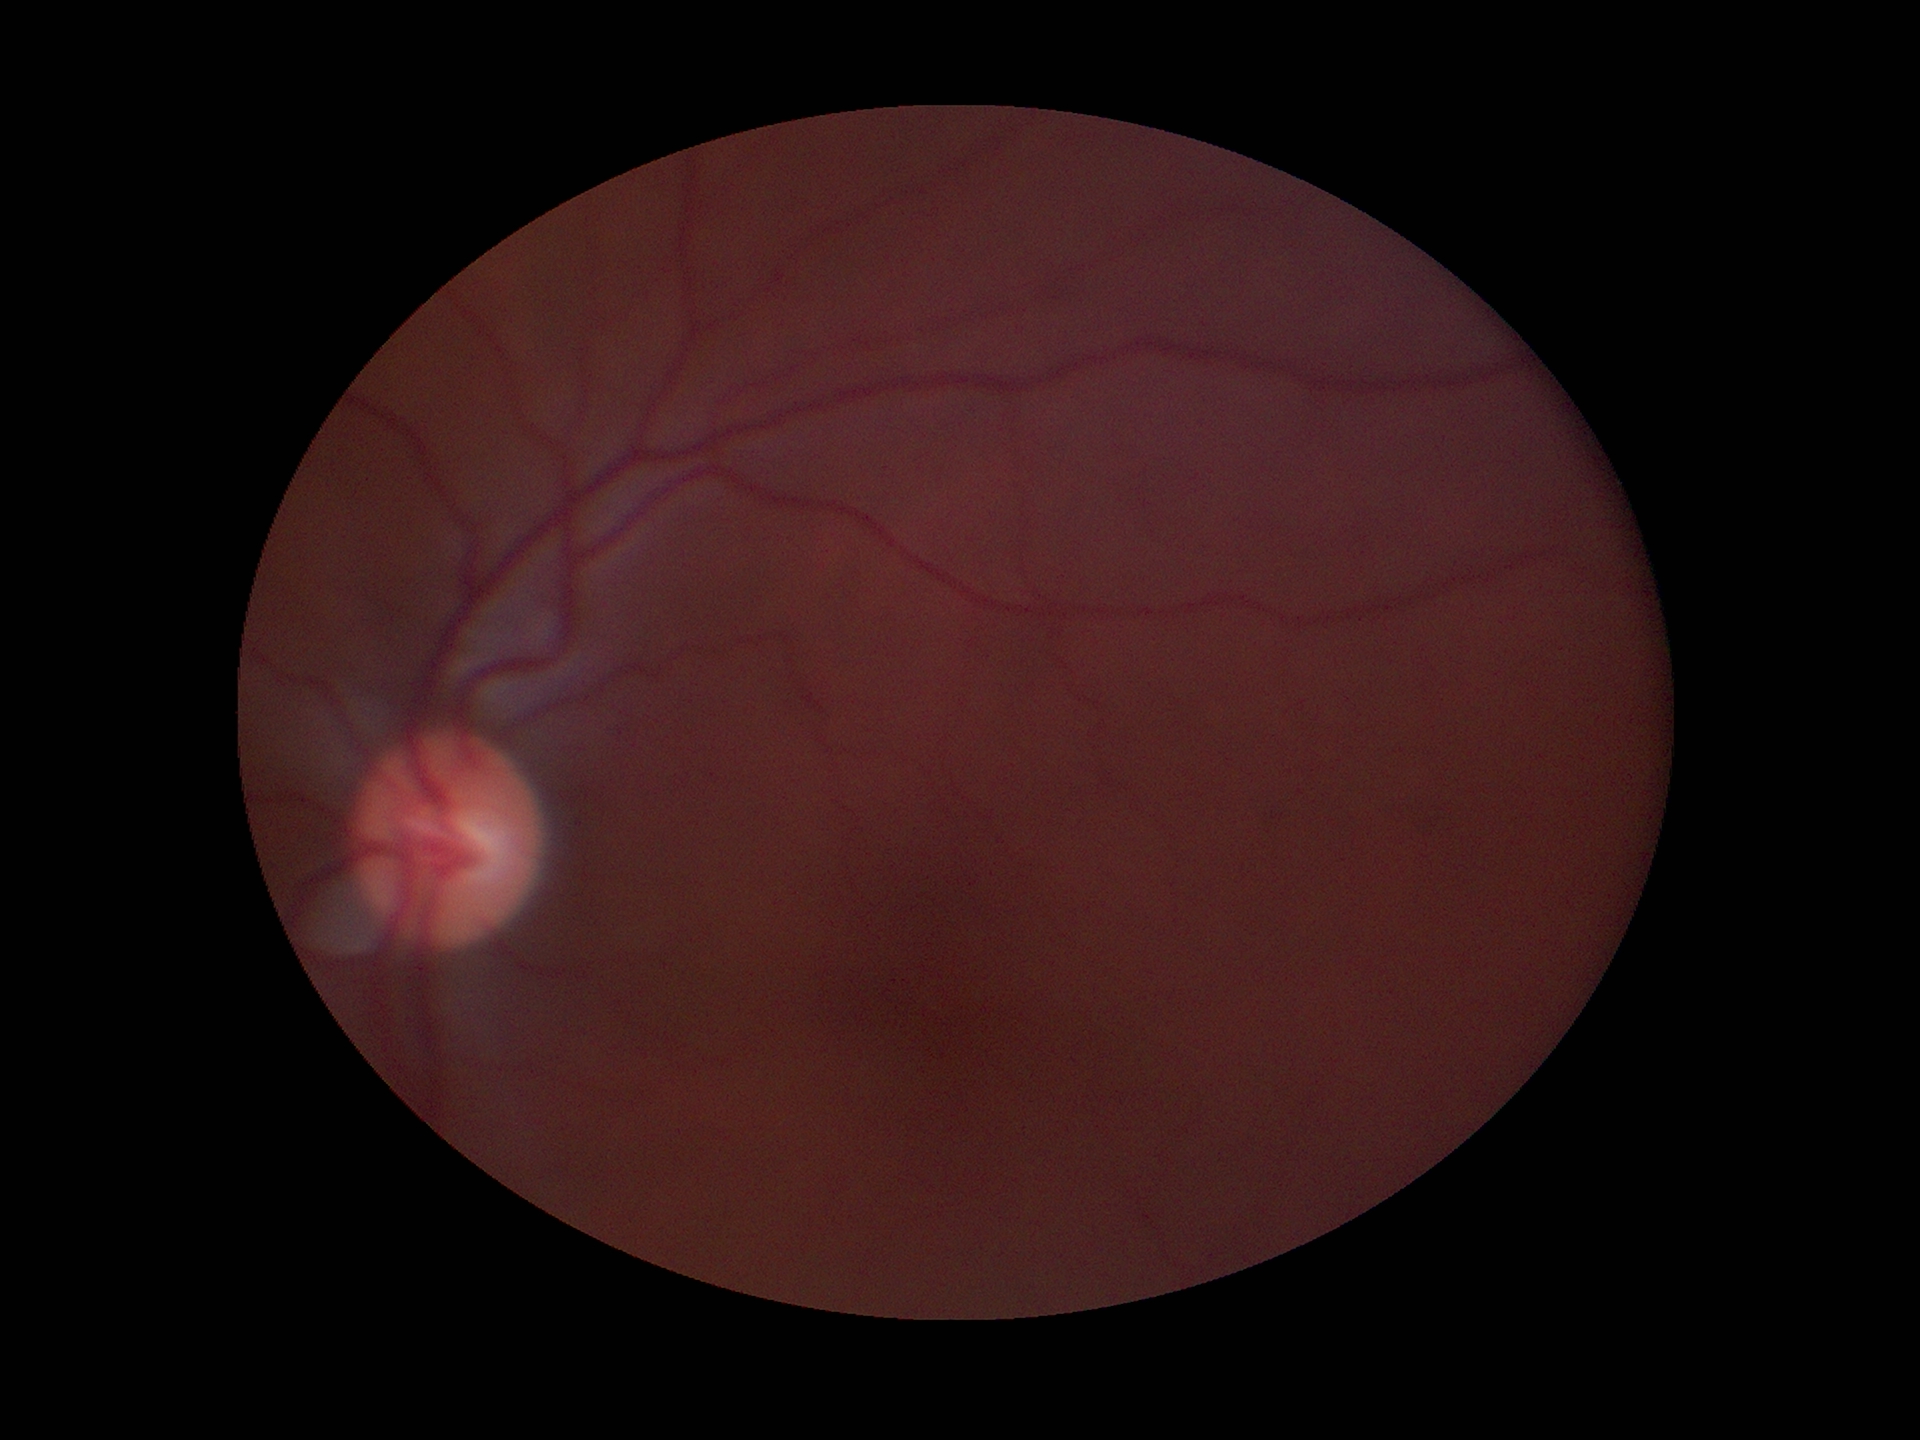

Glaucoma decision: negative; vertical C/D ratio (VCDR): 0.51